2352 x 1568 pixels.
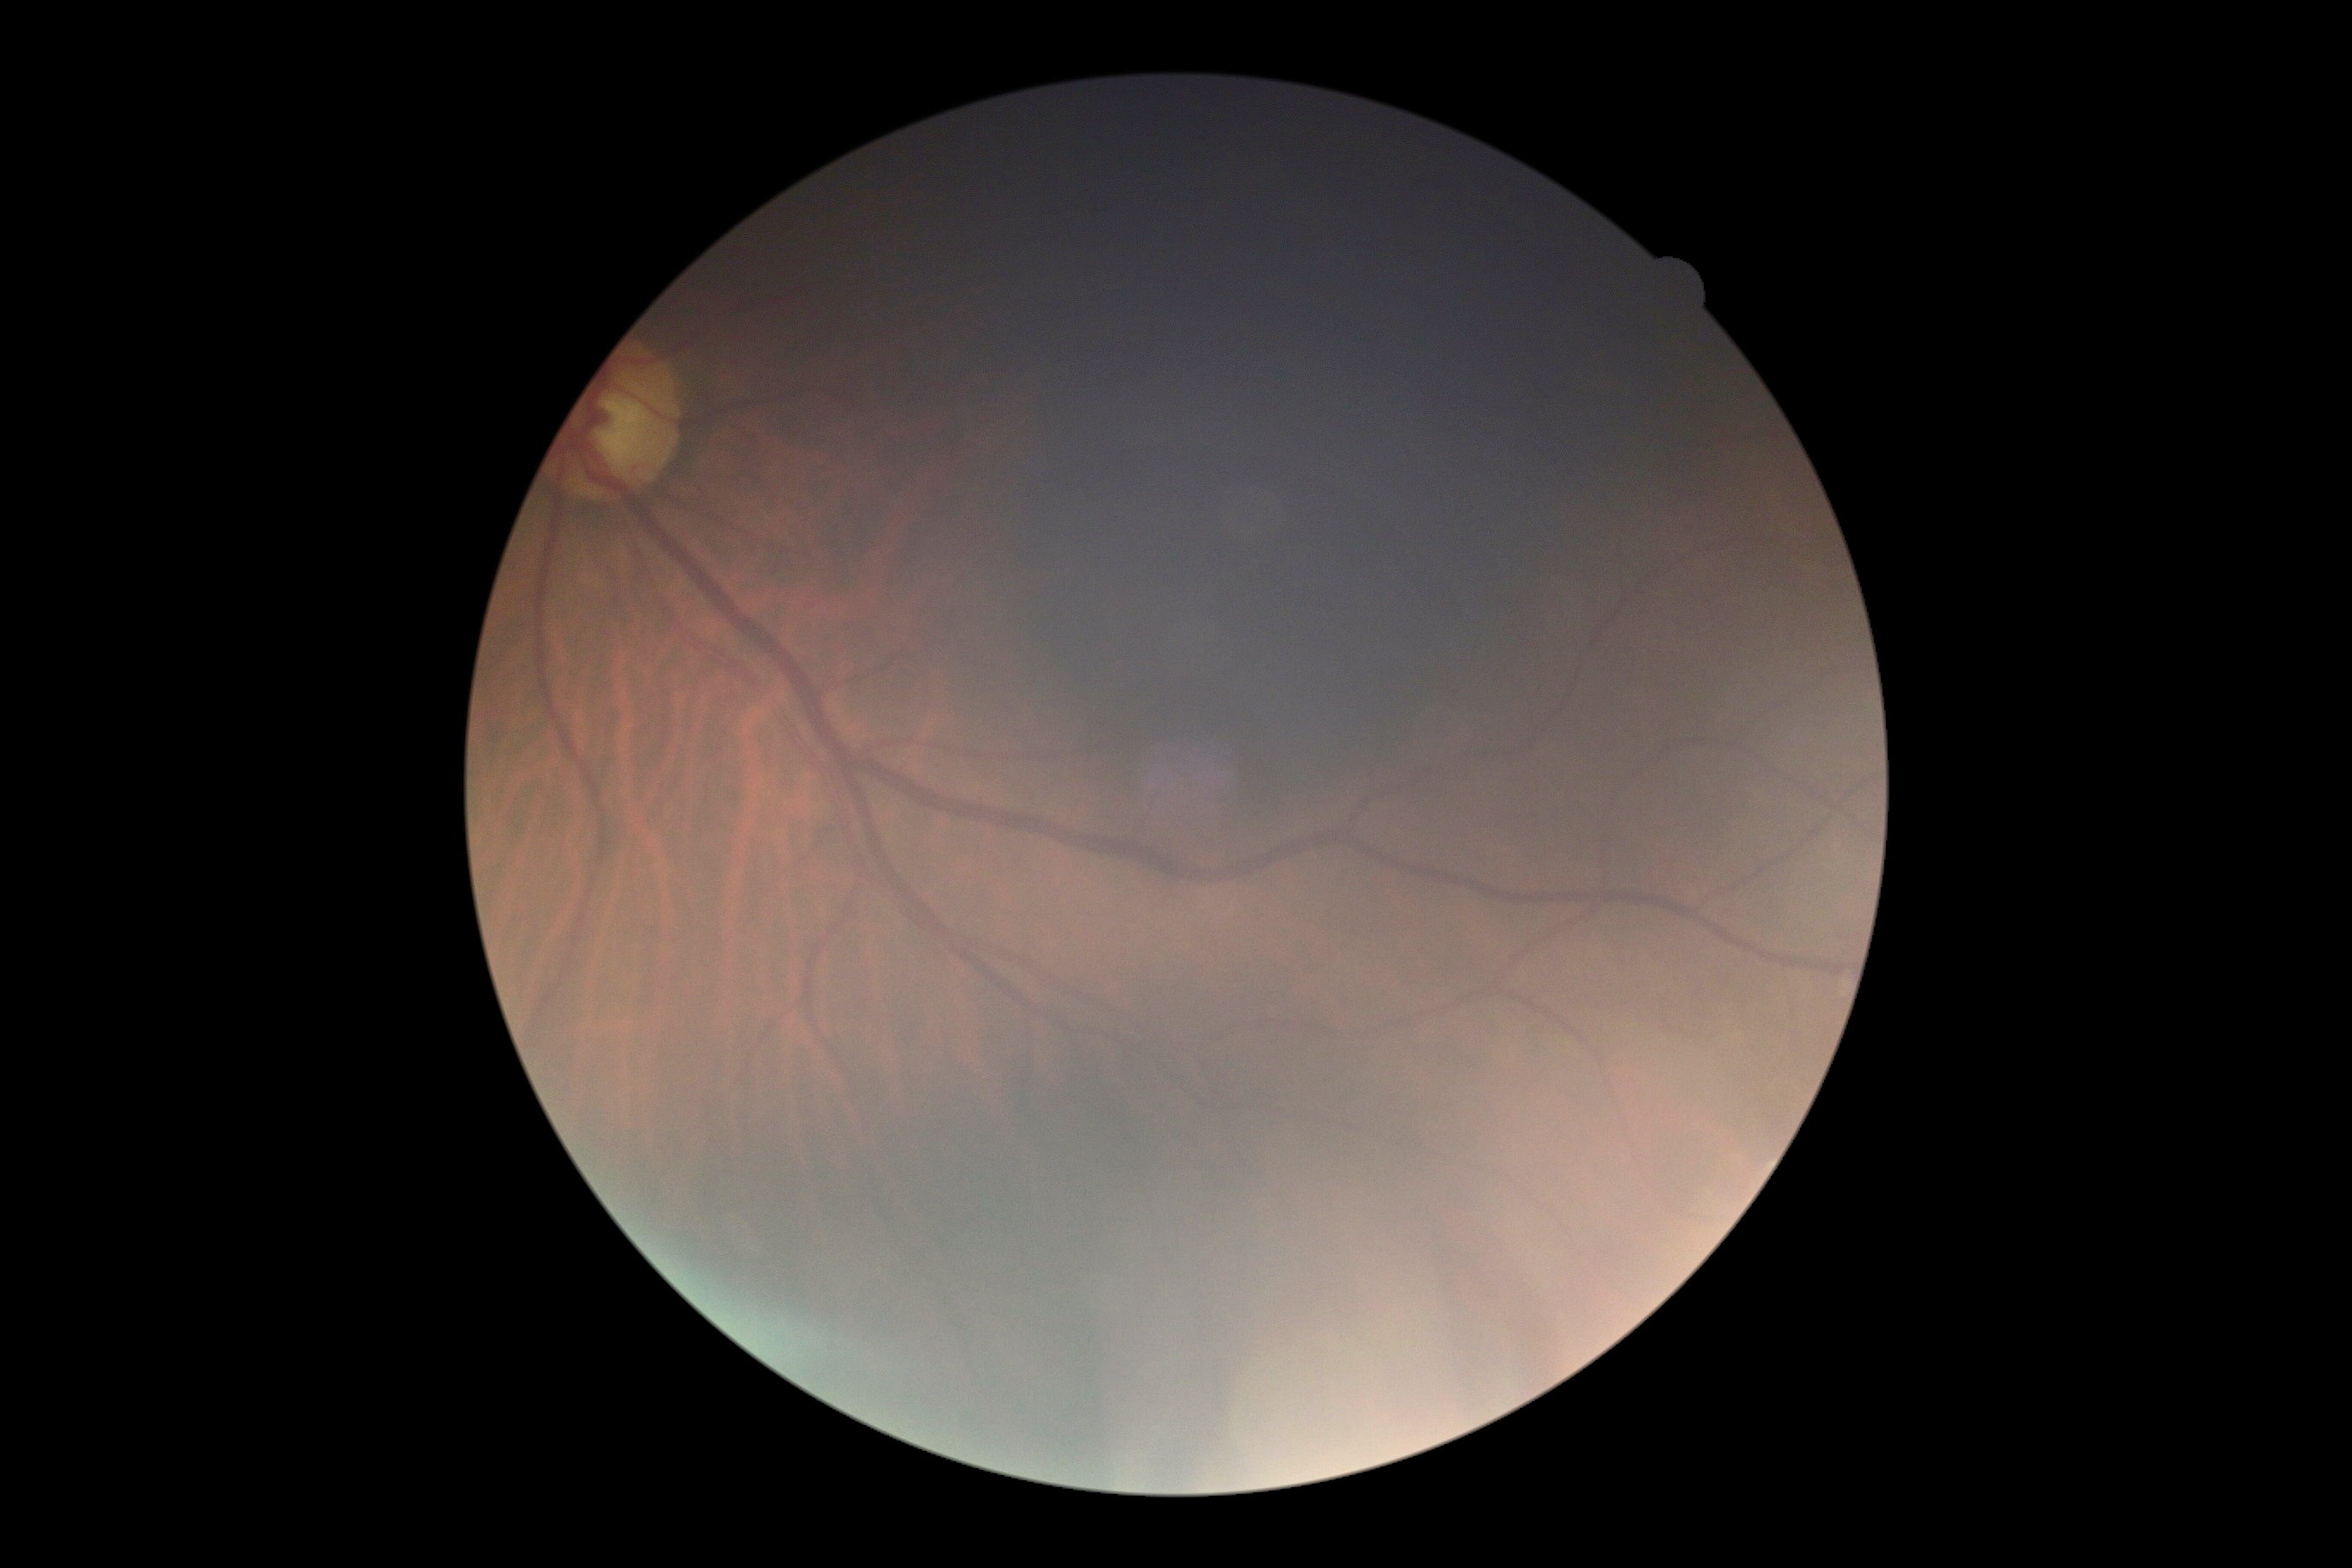
Retinopathy: ungradable due to poor image quality.